NIDEK AFC-230 fundus camera · without pupil dilation:
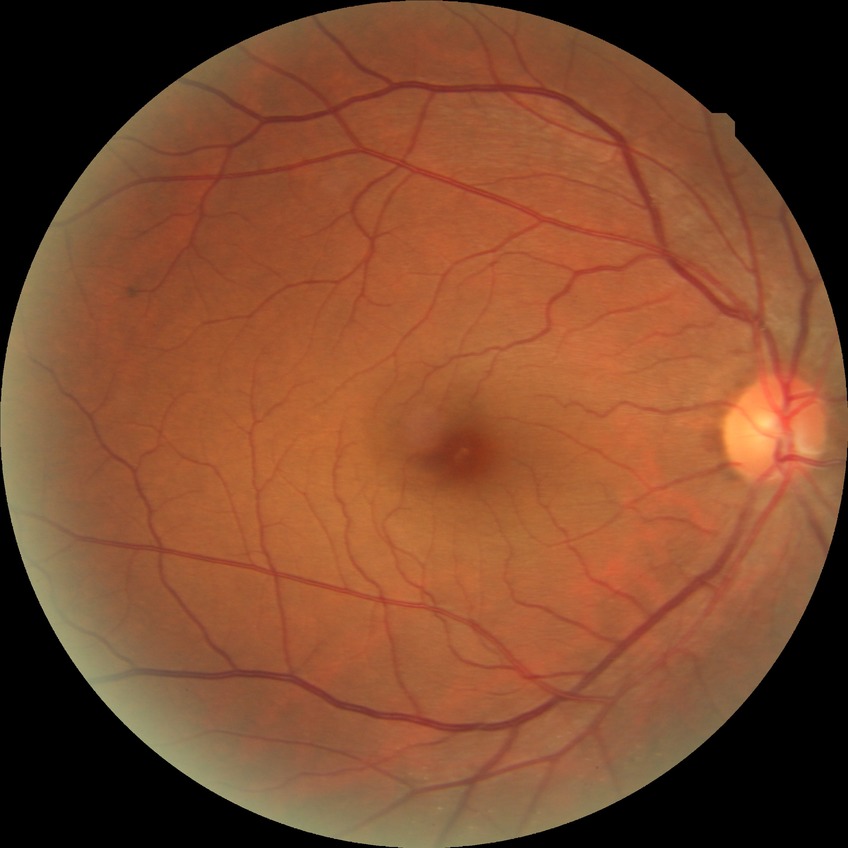

Diabetic retinopathy (DR): NDR (no diabetic retinopathy).